Without pupil dilation, modified Davis grading: 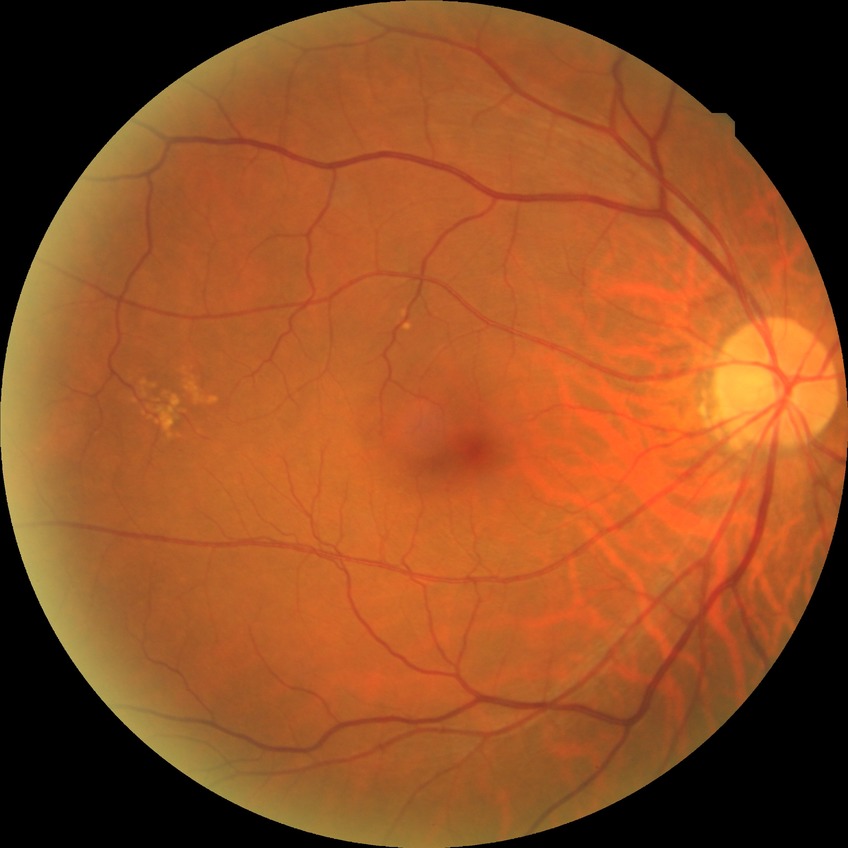 - modified Davis classification: no diabetic retinopathy